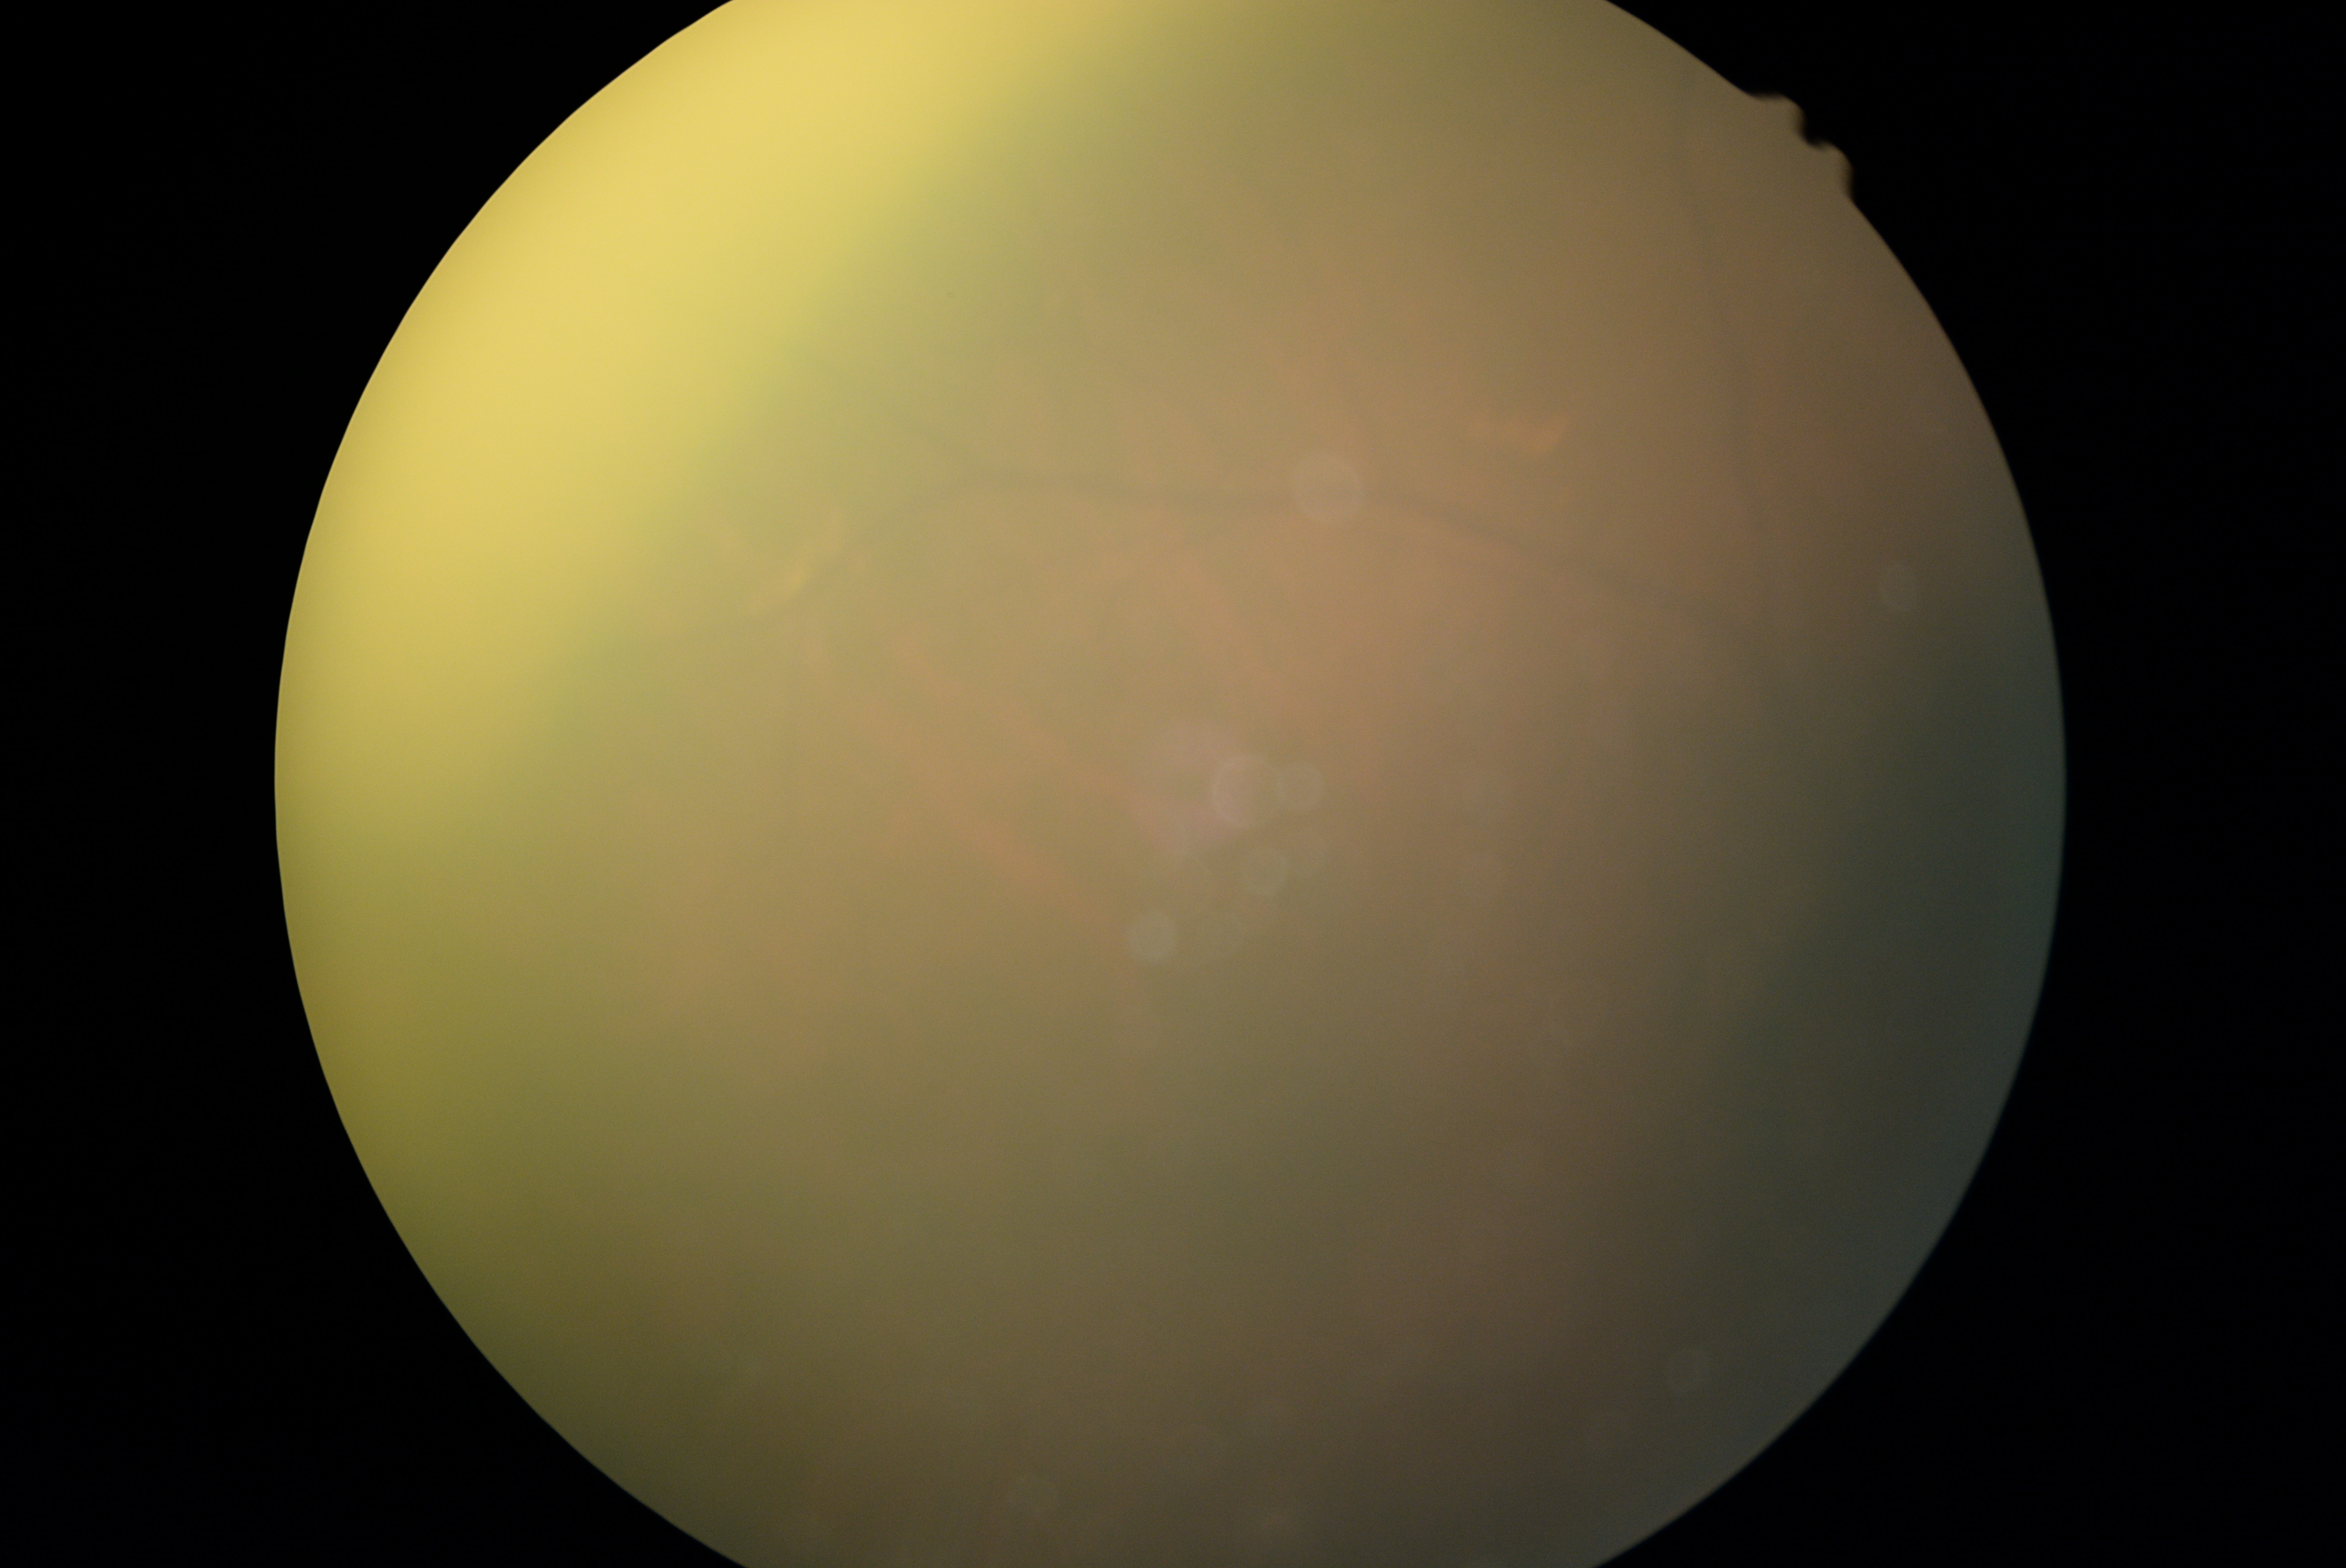

DR grade: ungradable due to poor image quality.